Color fundus photograph; pupil-dilated: 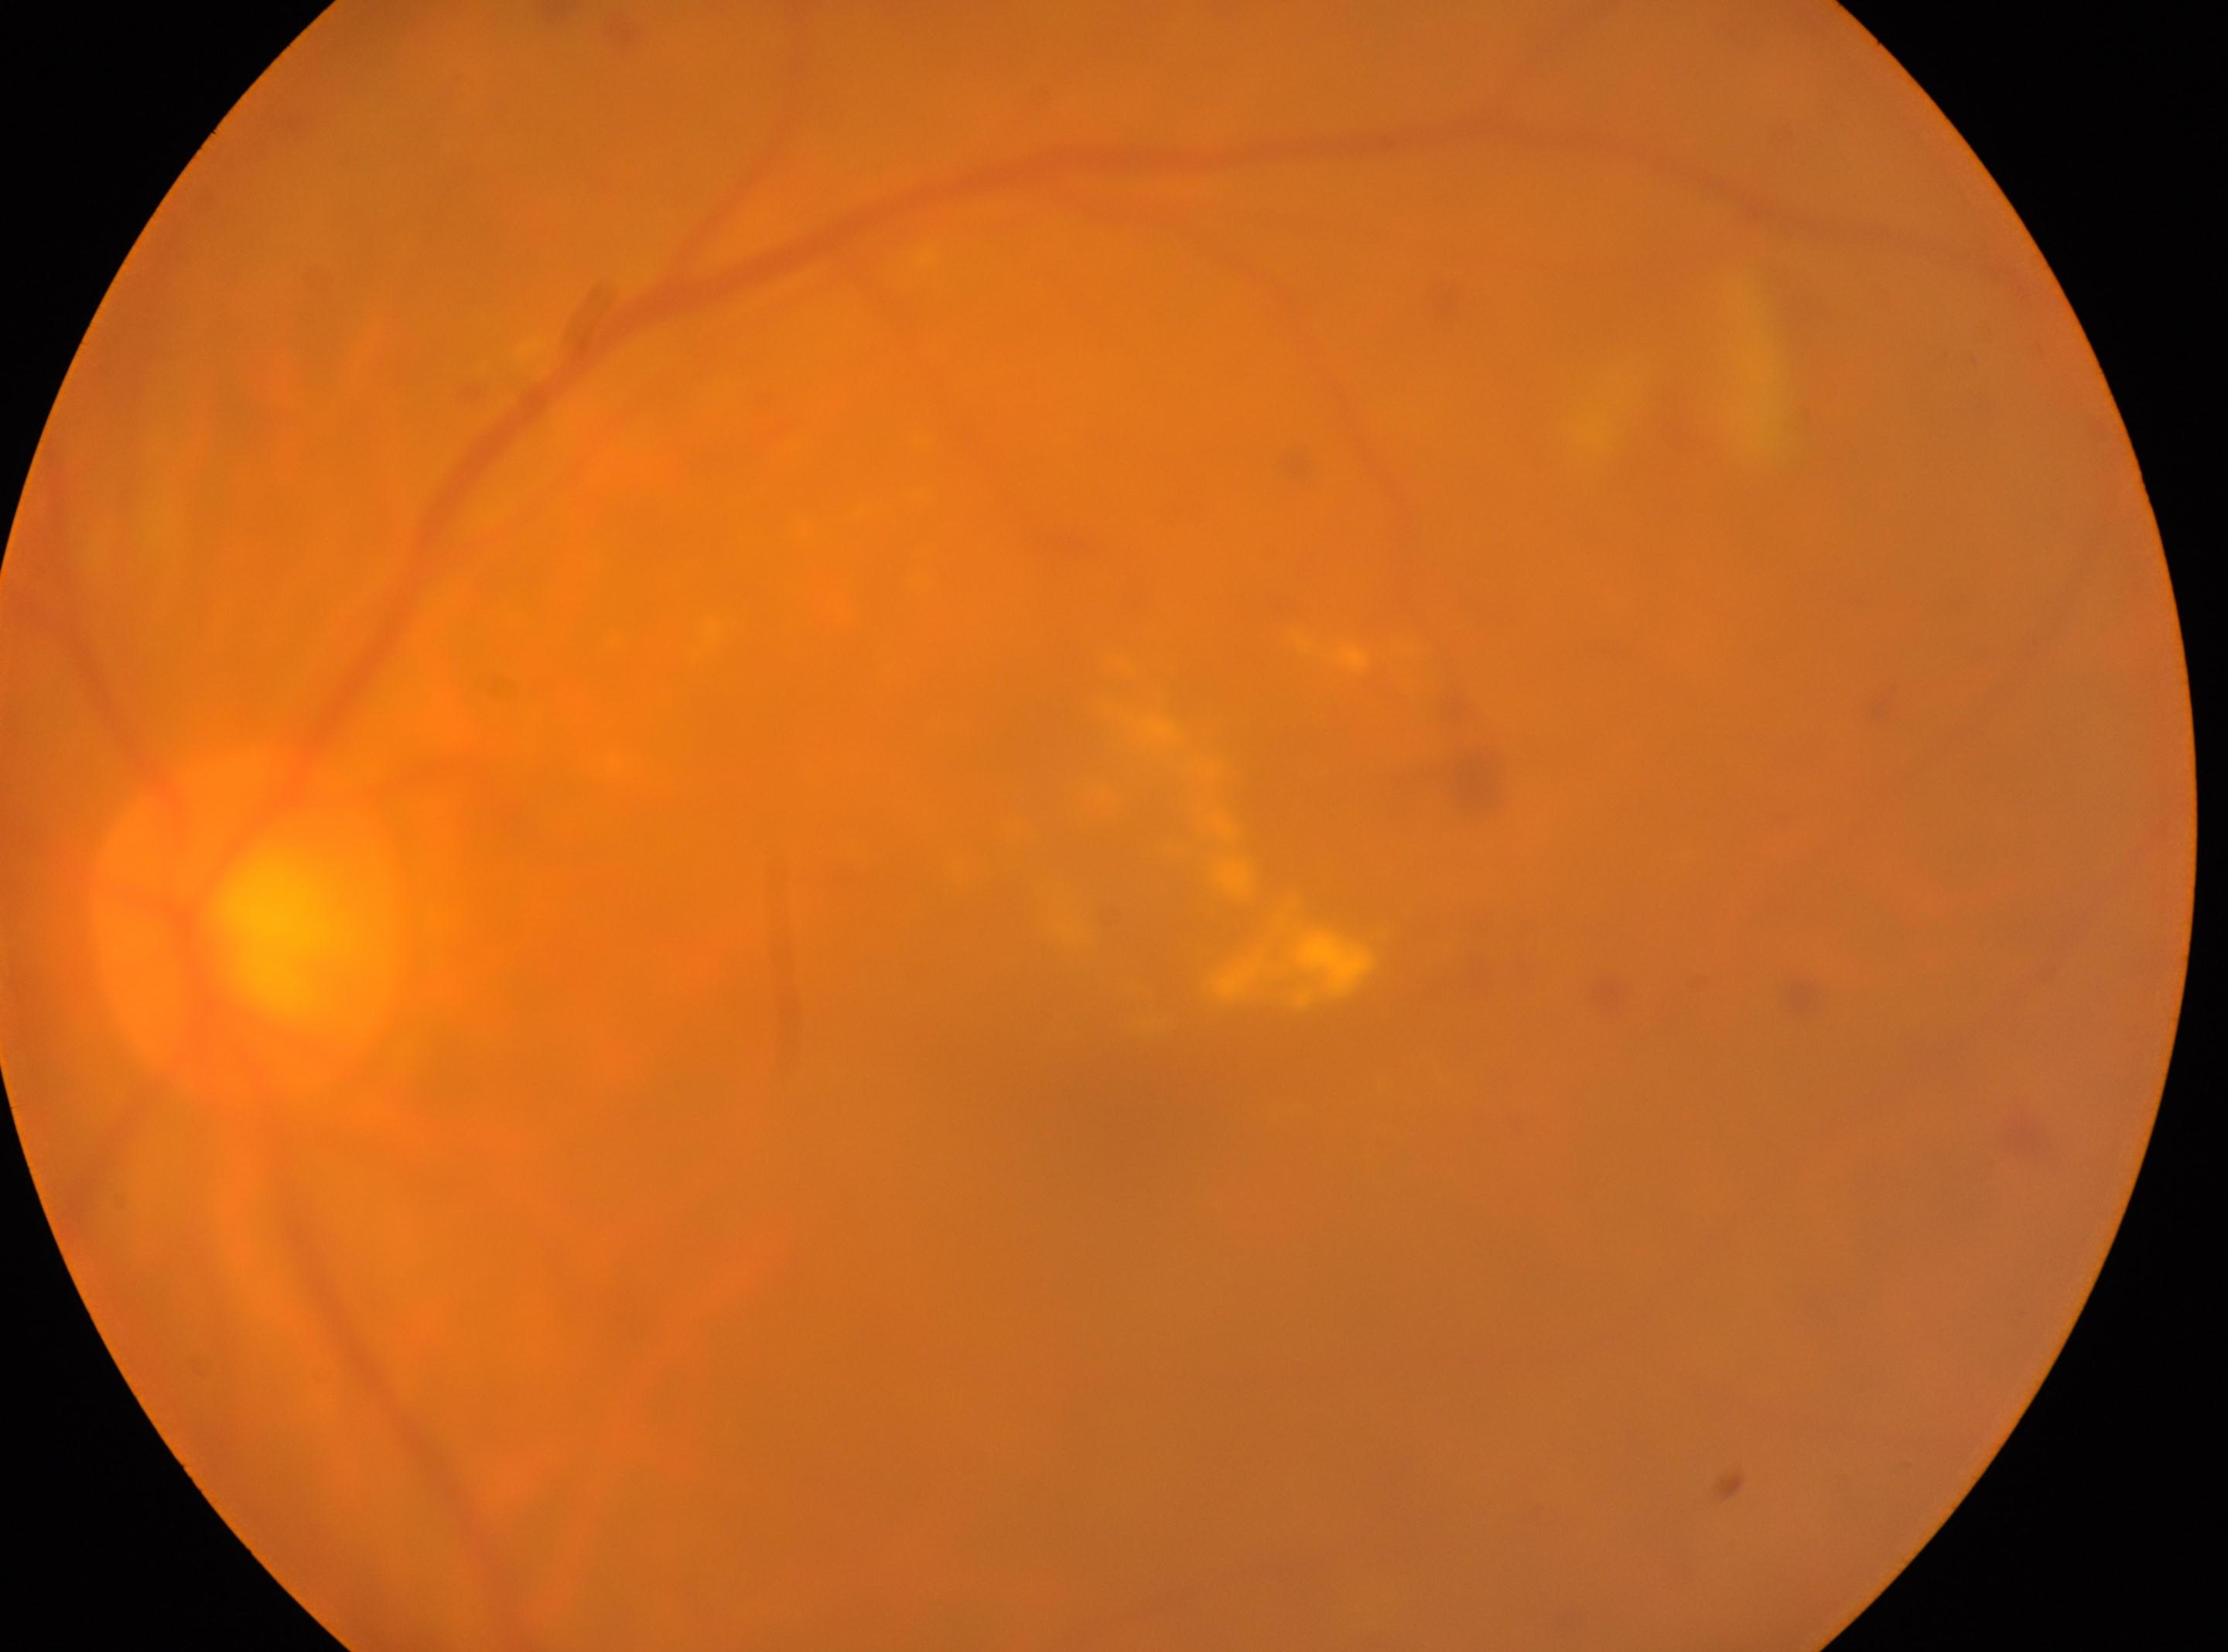

Disc center located at (x: 245, y: 929).
This is the left eye.
DR grade is 2.
Fovea located at (x: 1126, y: 1120).